Remidio Fundus on Phone (FOP) camera:
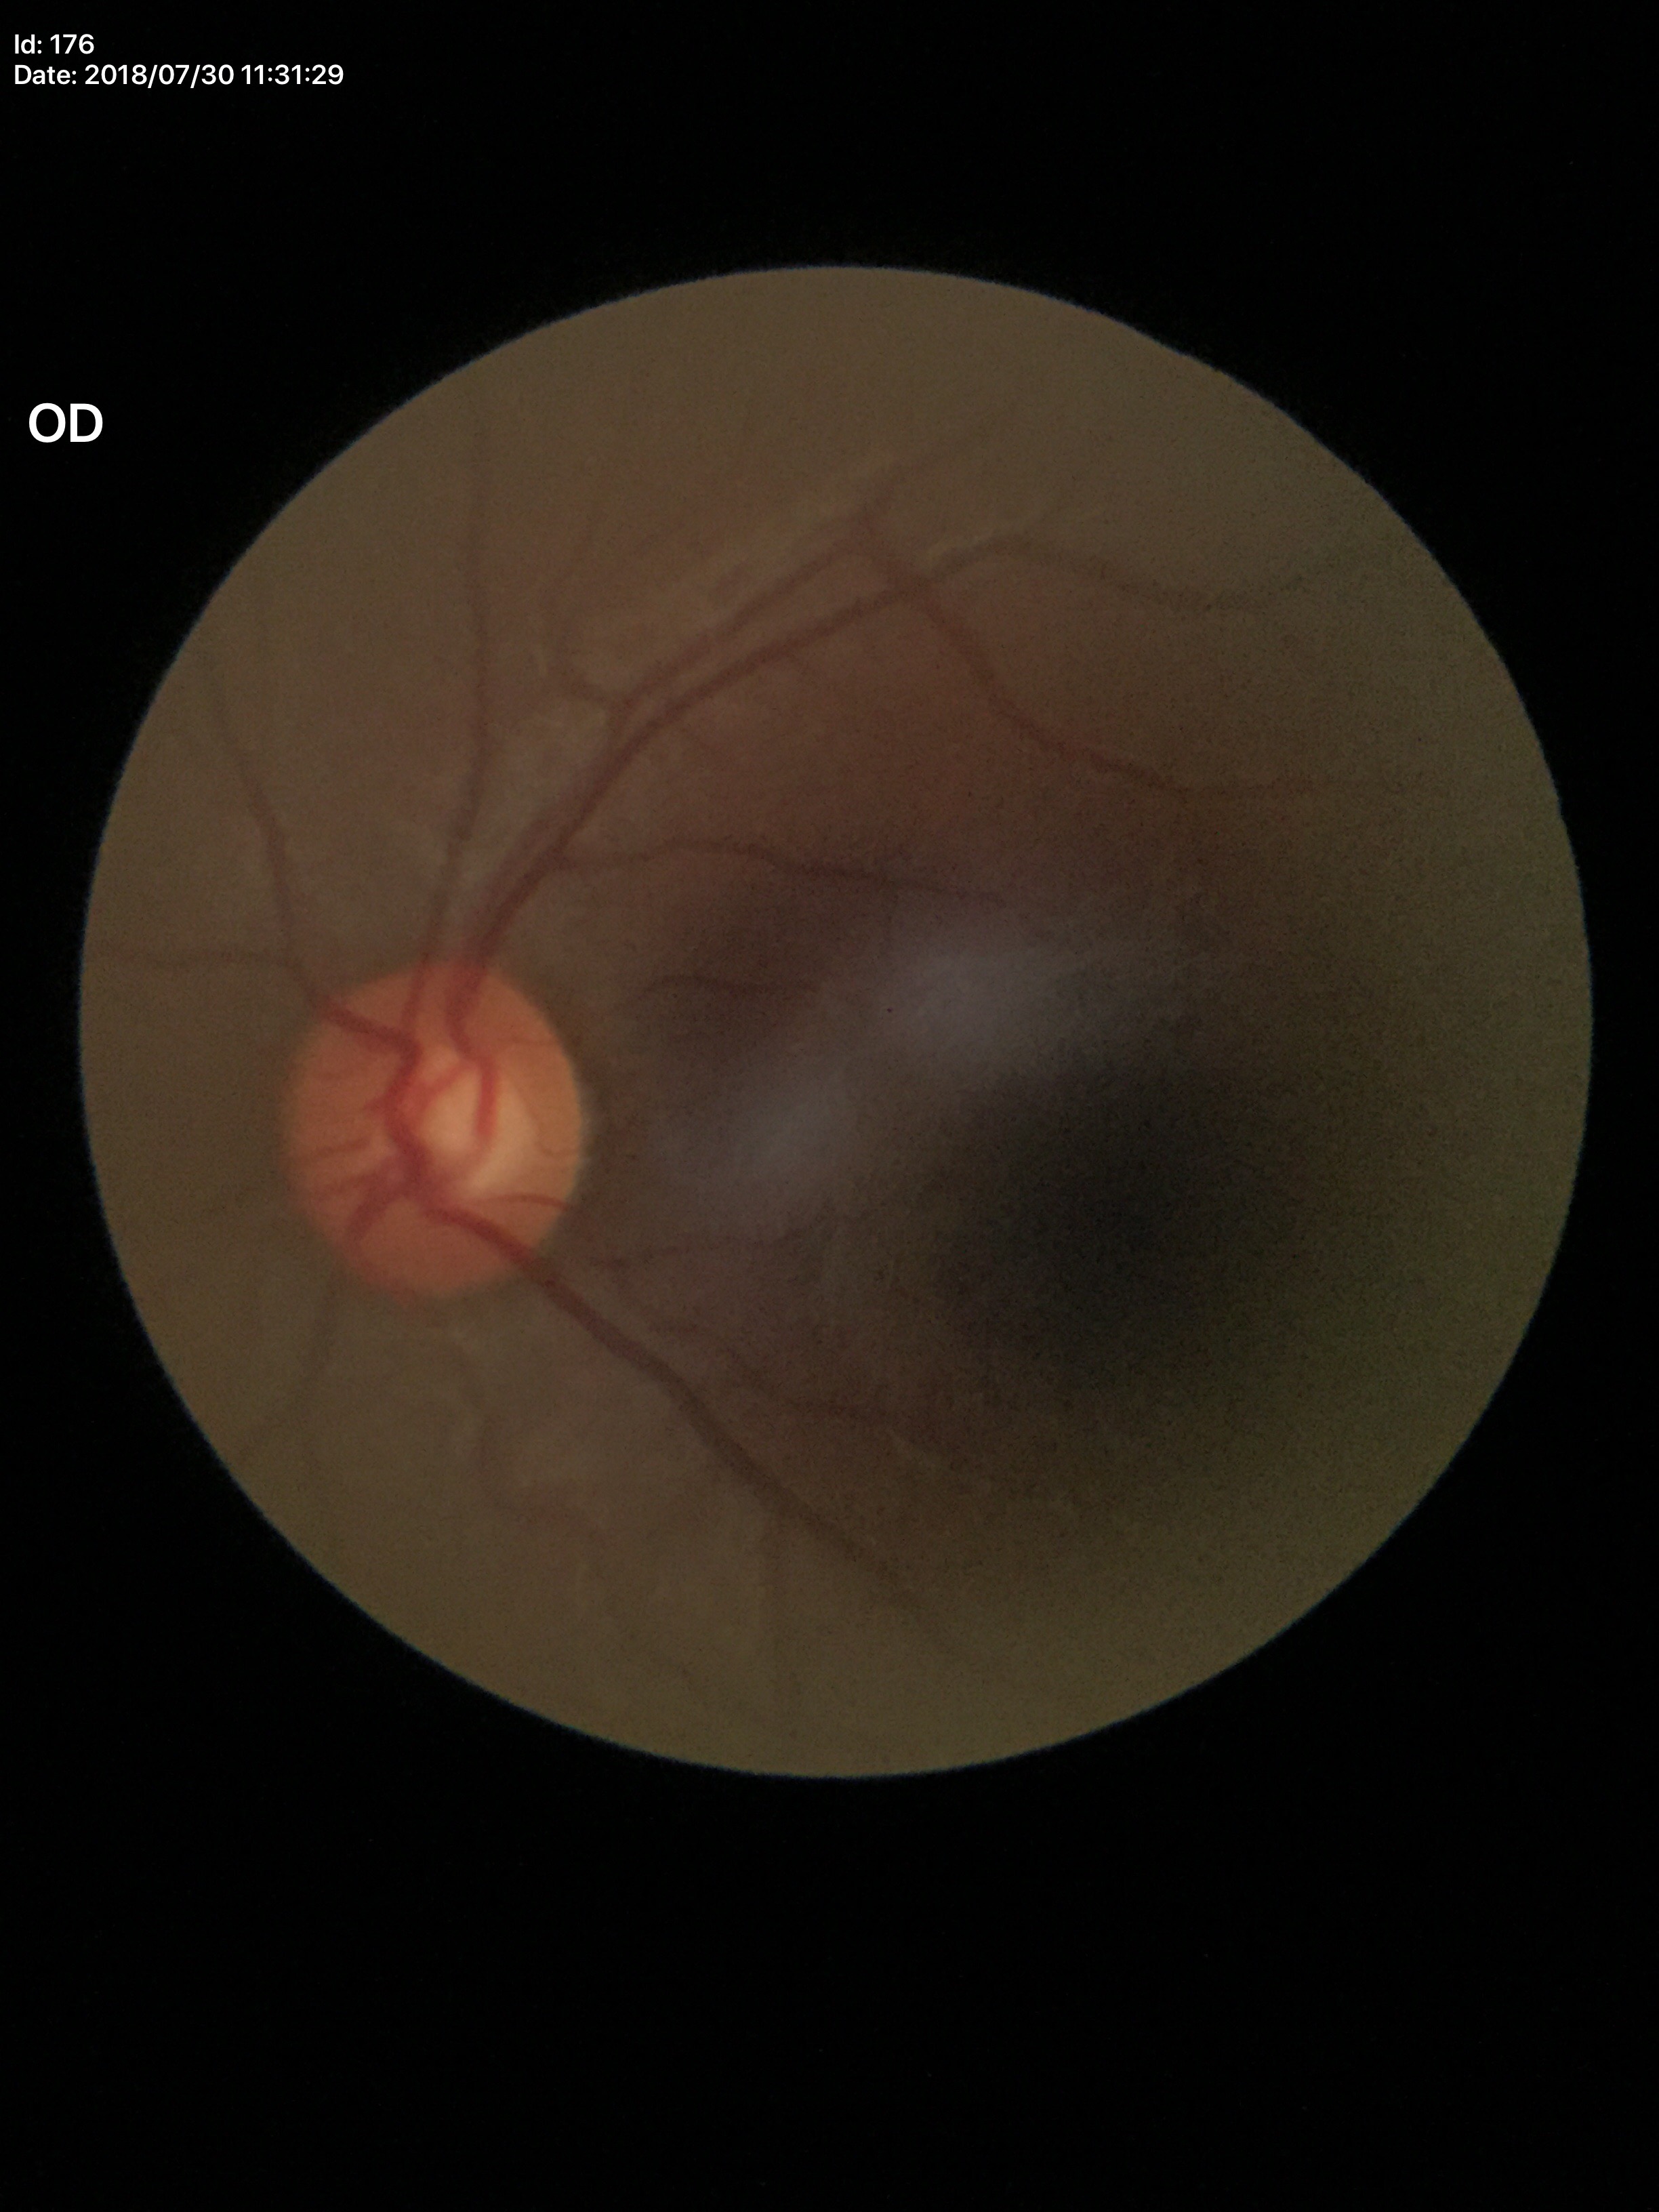 Glaucoma impression: negative (5/5 ophthalmologists in agreement). VCDR of 0.52. HCDR of 0.56.